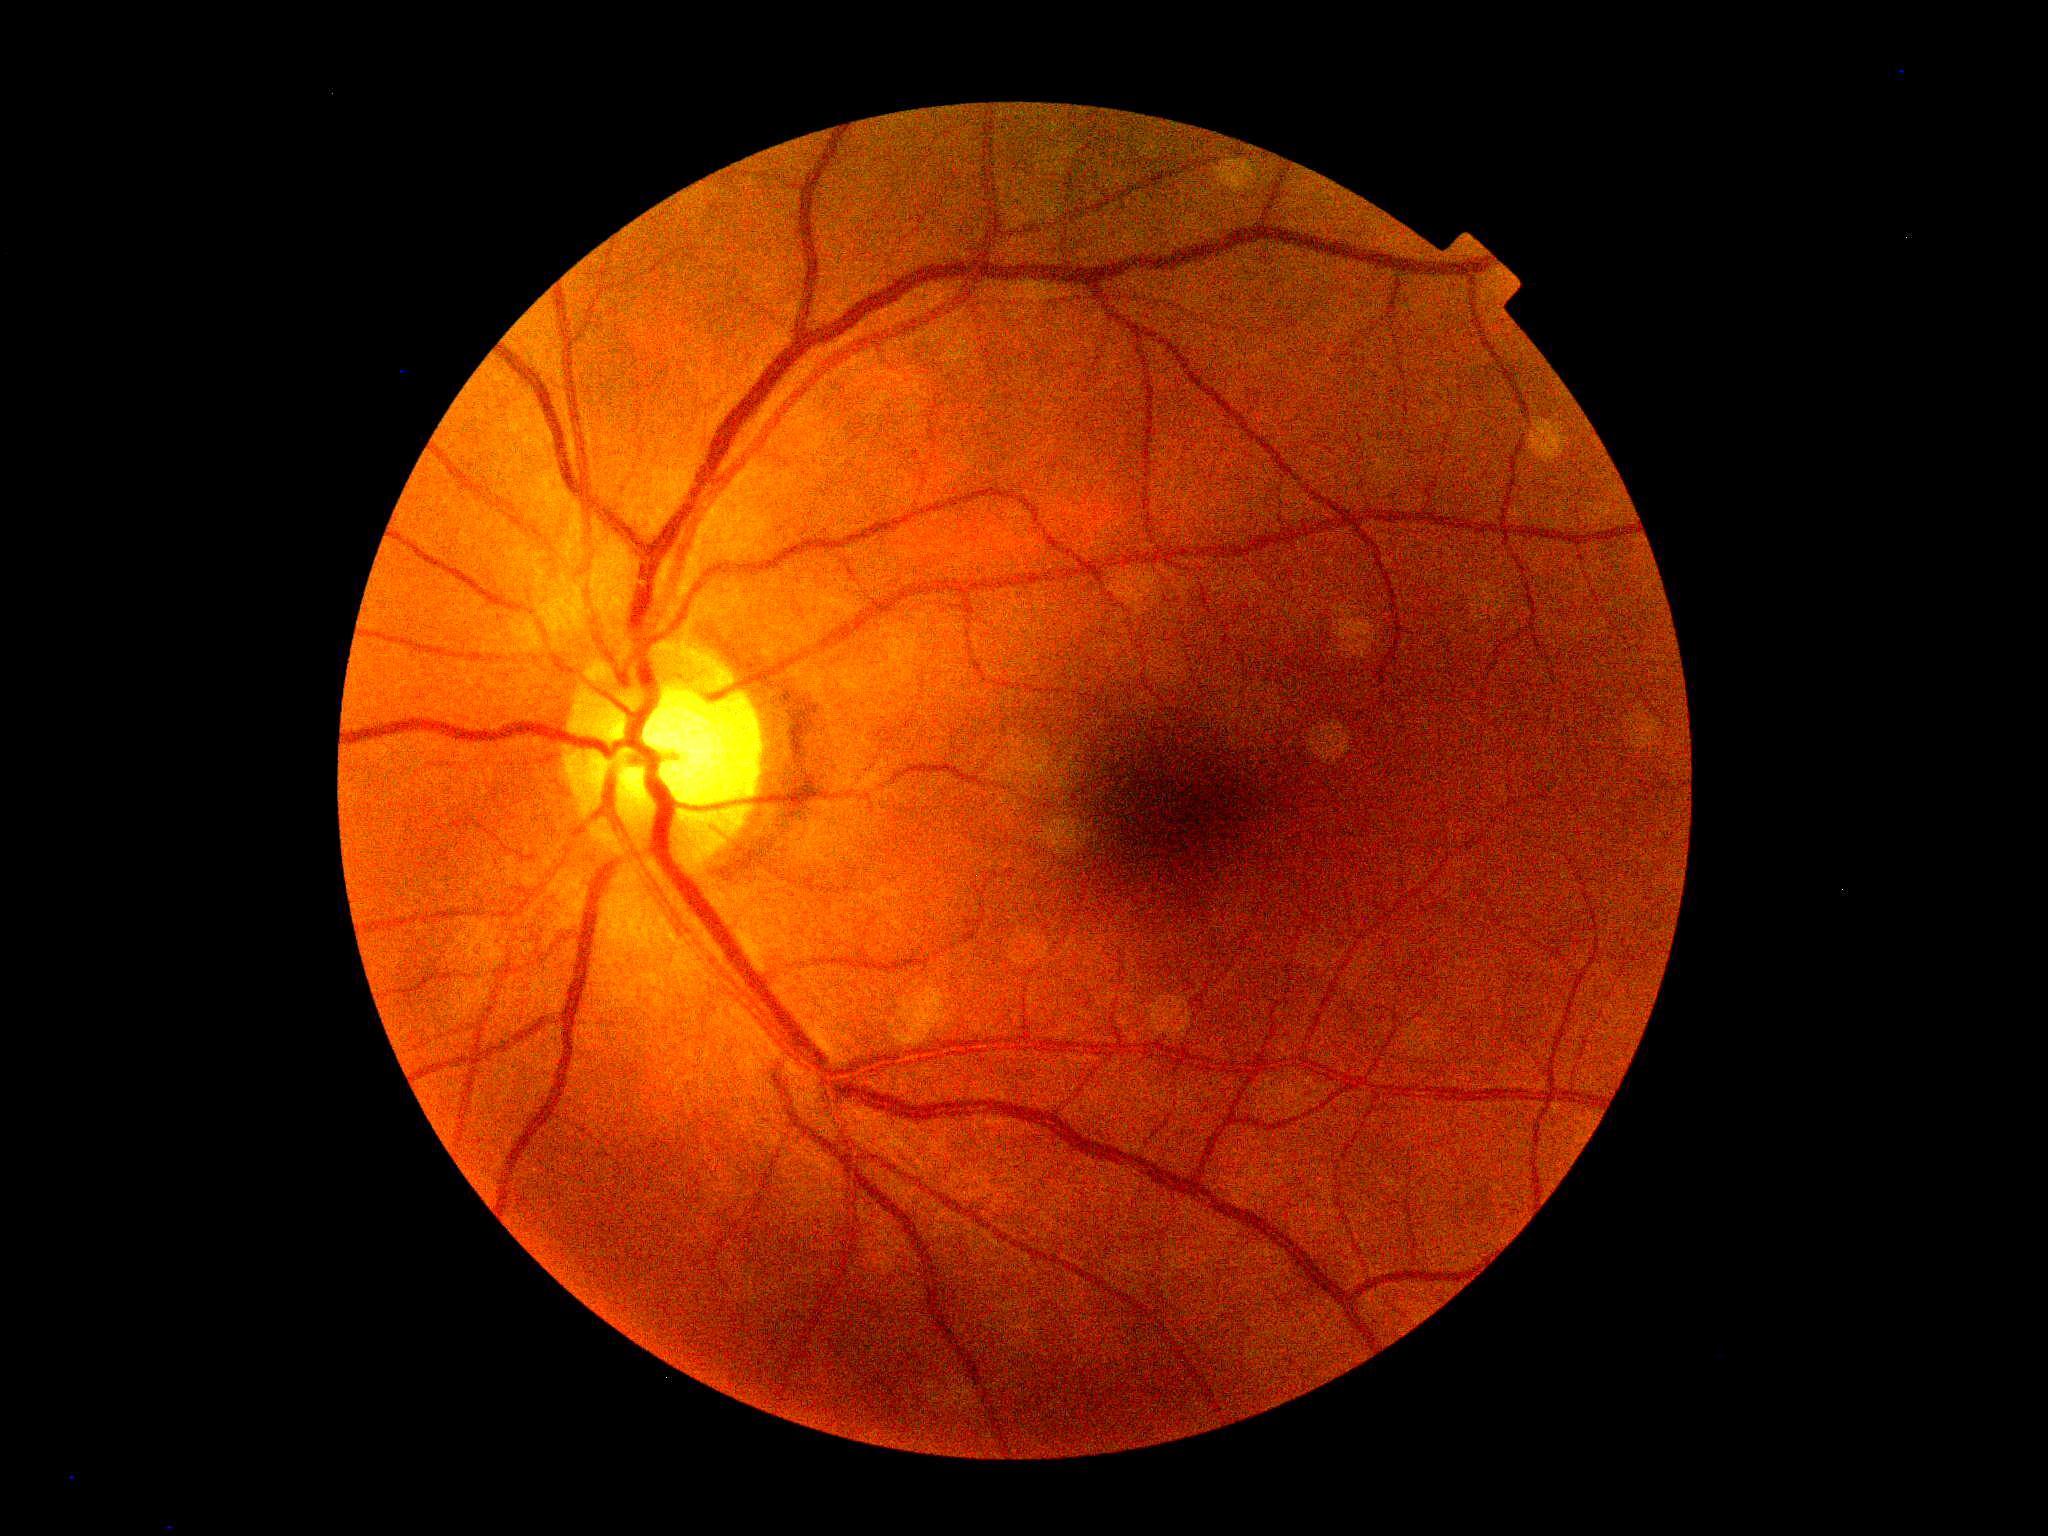
Findings:
- DR grade: 0
- DR impression: negative for DR